Fundus photograph cropped around the optic nerve head; cropped from a 35-degree field of view:
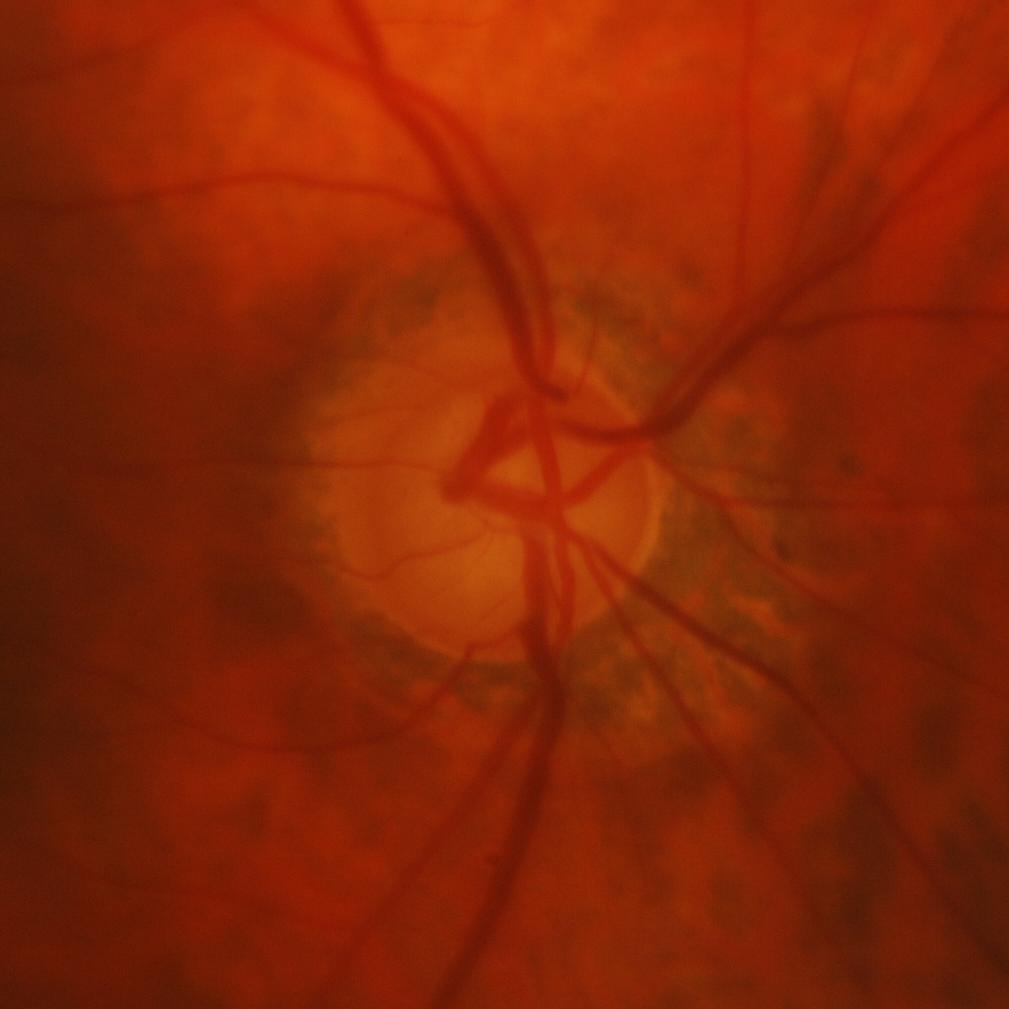

Q: Is there glaucomatous optic neuropathy?
A: Glaucomatous changes.